Field includes the optic disc and macula
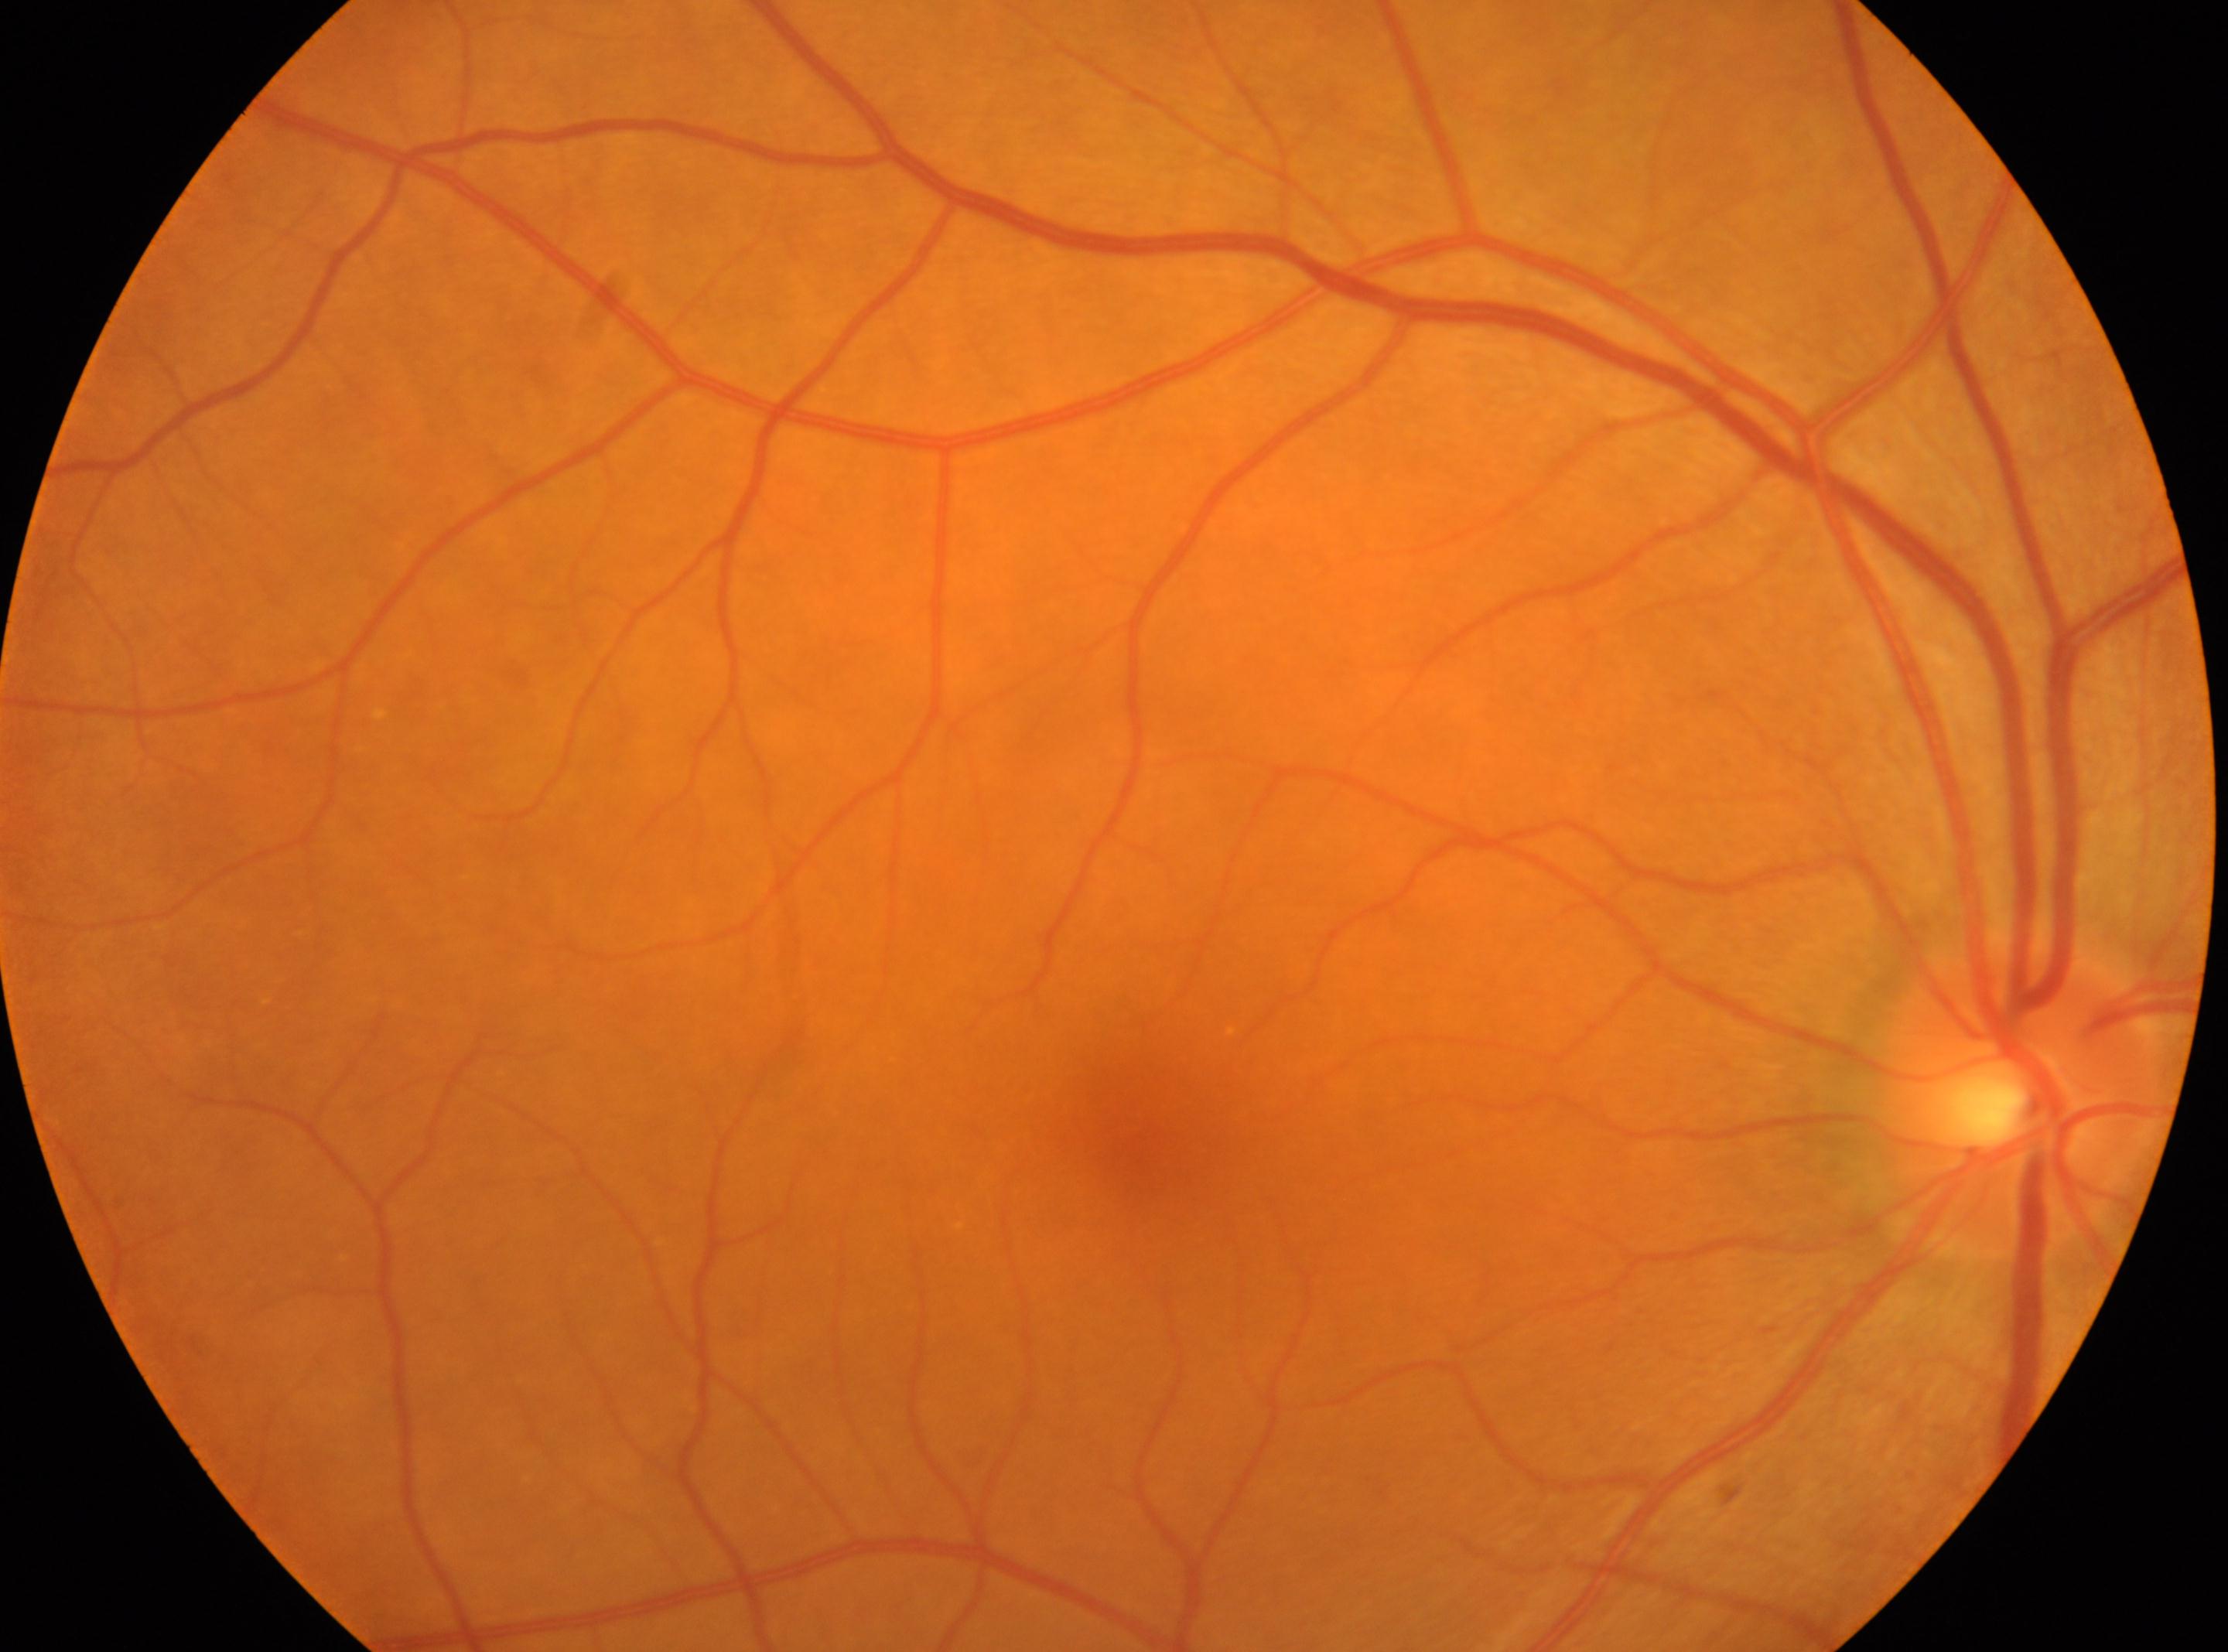

The macular center is at [1134, 1118]. The optic disc is at [2016, 1095]. No diabetic retinal disease findings. Imaged eye: OD. Diabetic retinopathy: 0/4.